2352 x 1568 pixels: 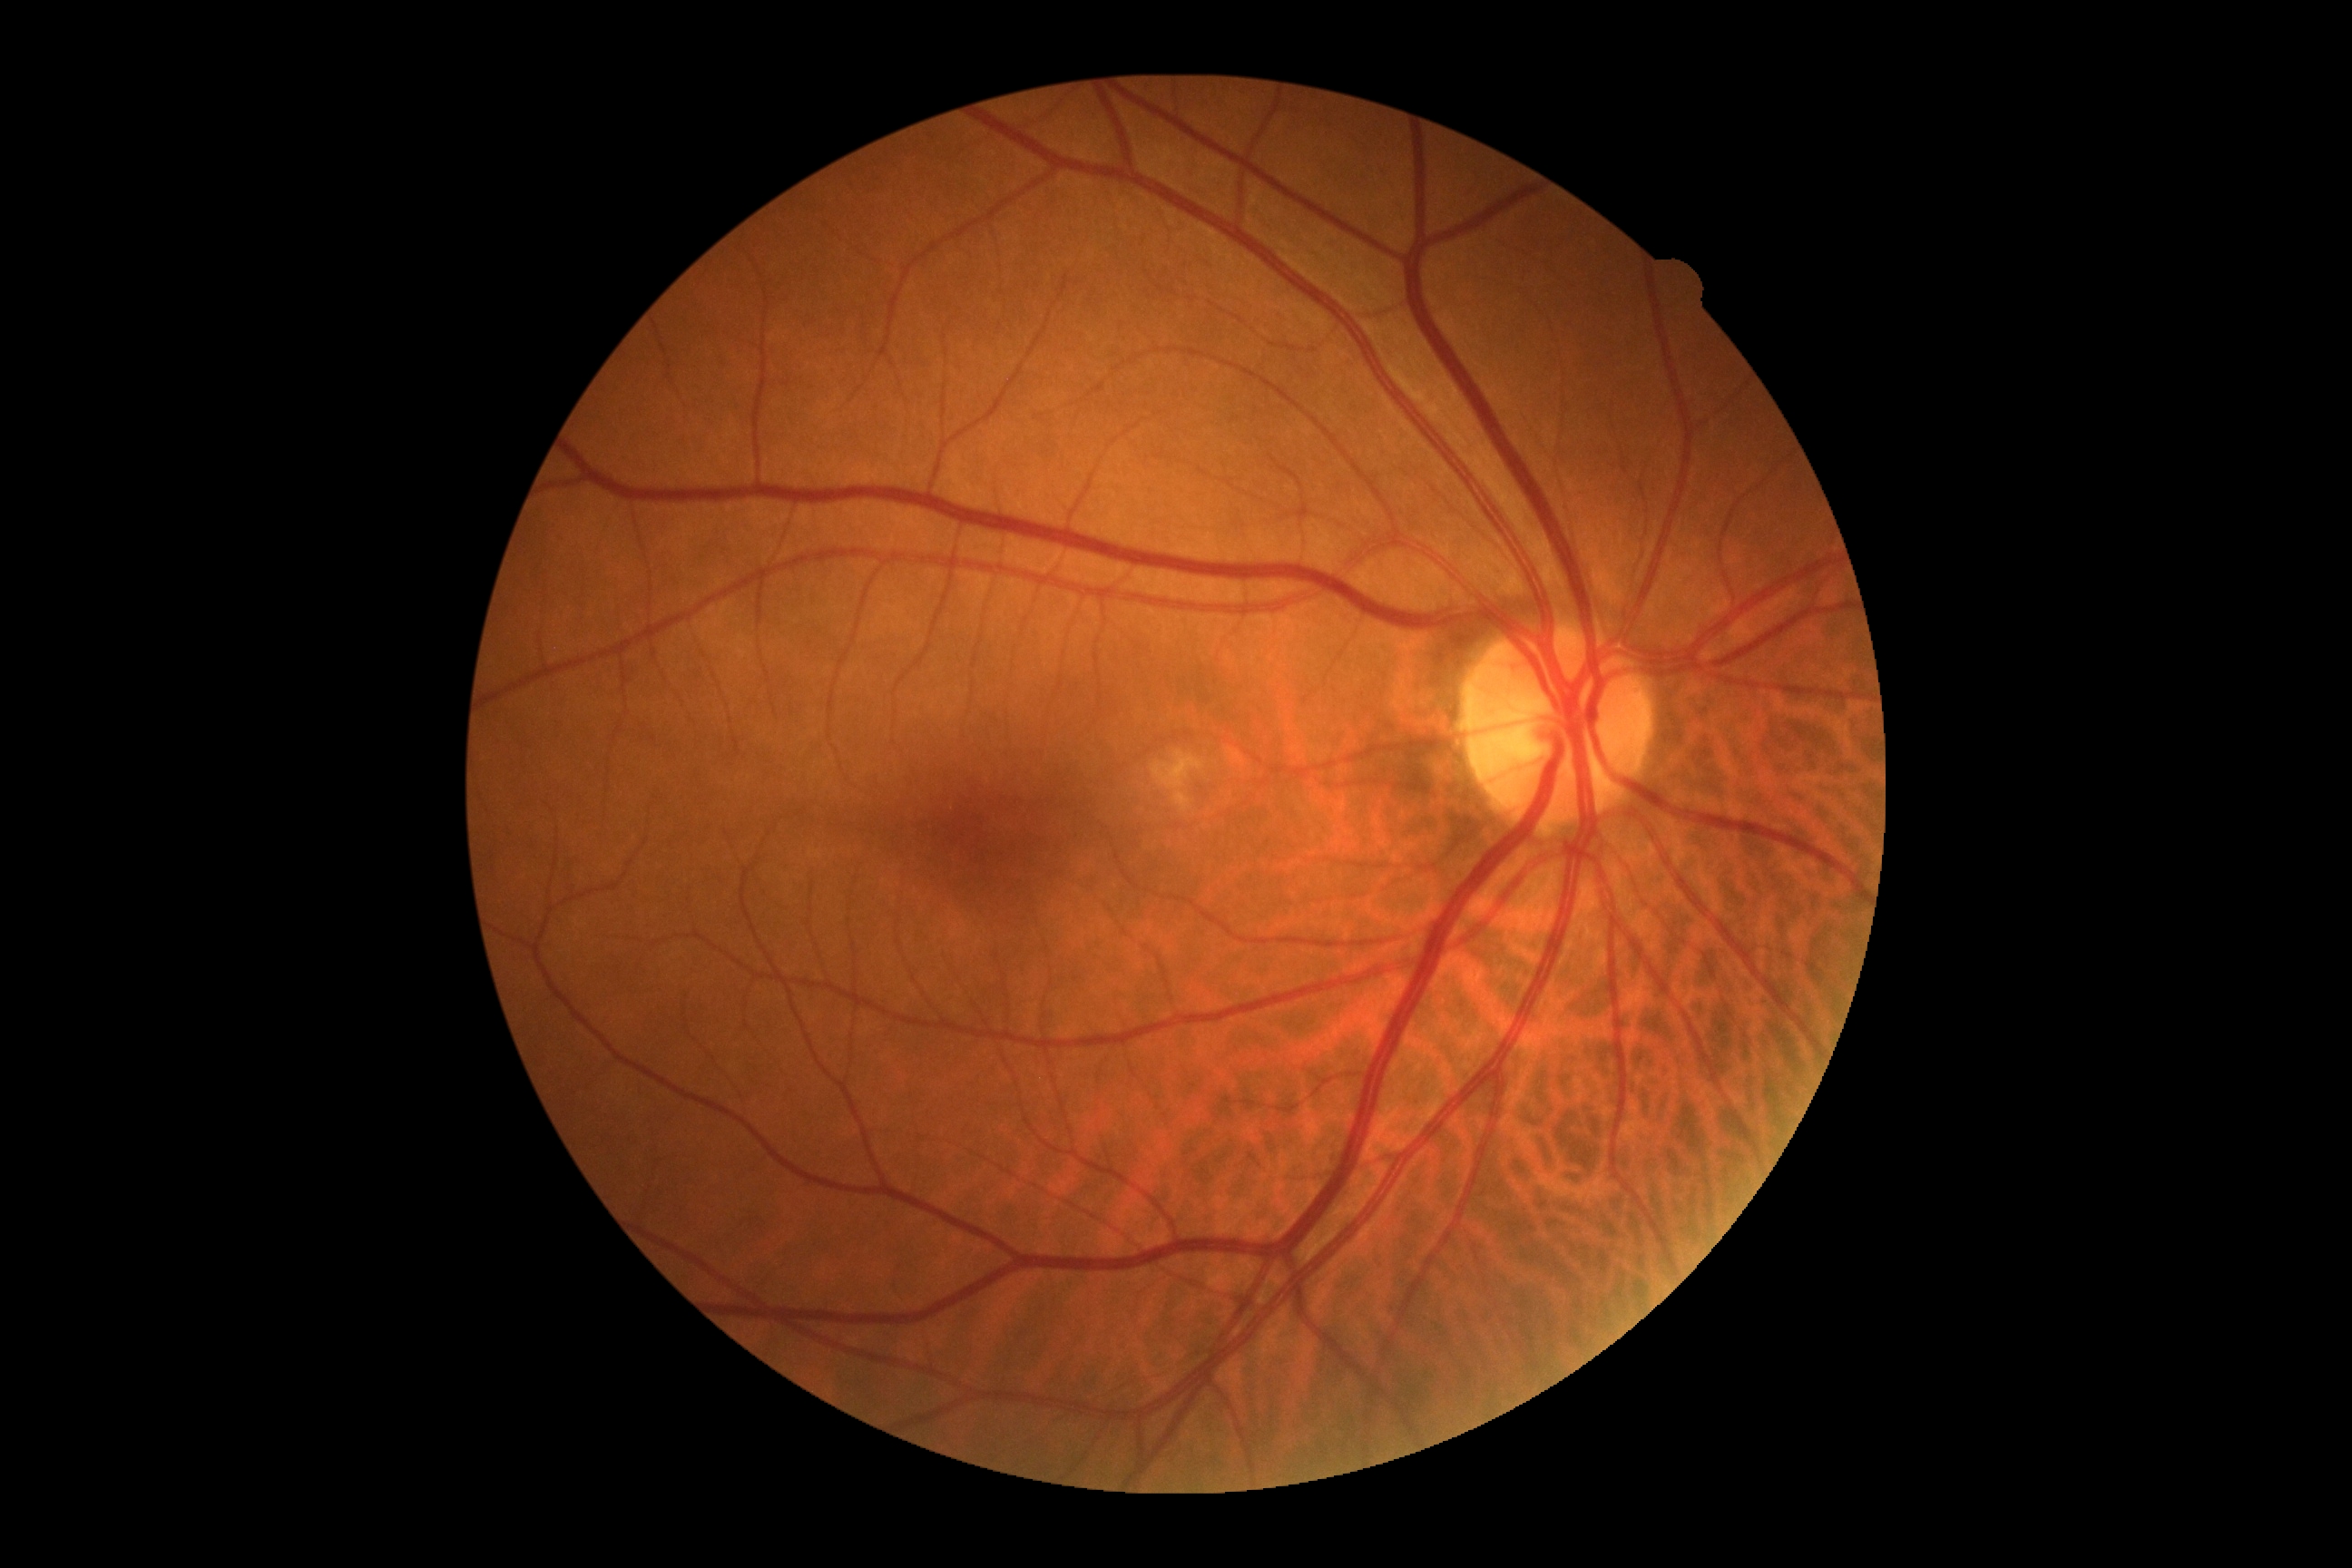

Diabetic retinopathy is no apparent diabetic retinopathy (grade 0). No diabetic retinal disease findings.